Central posterior field, 50° field of view, CFP
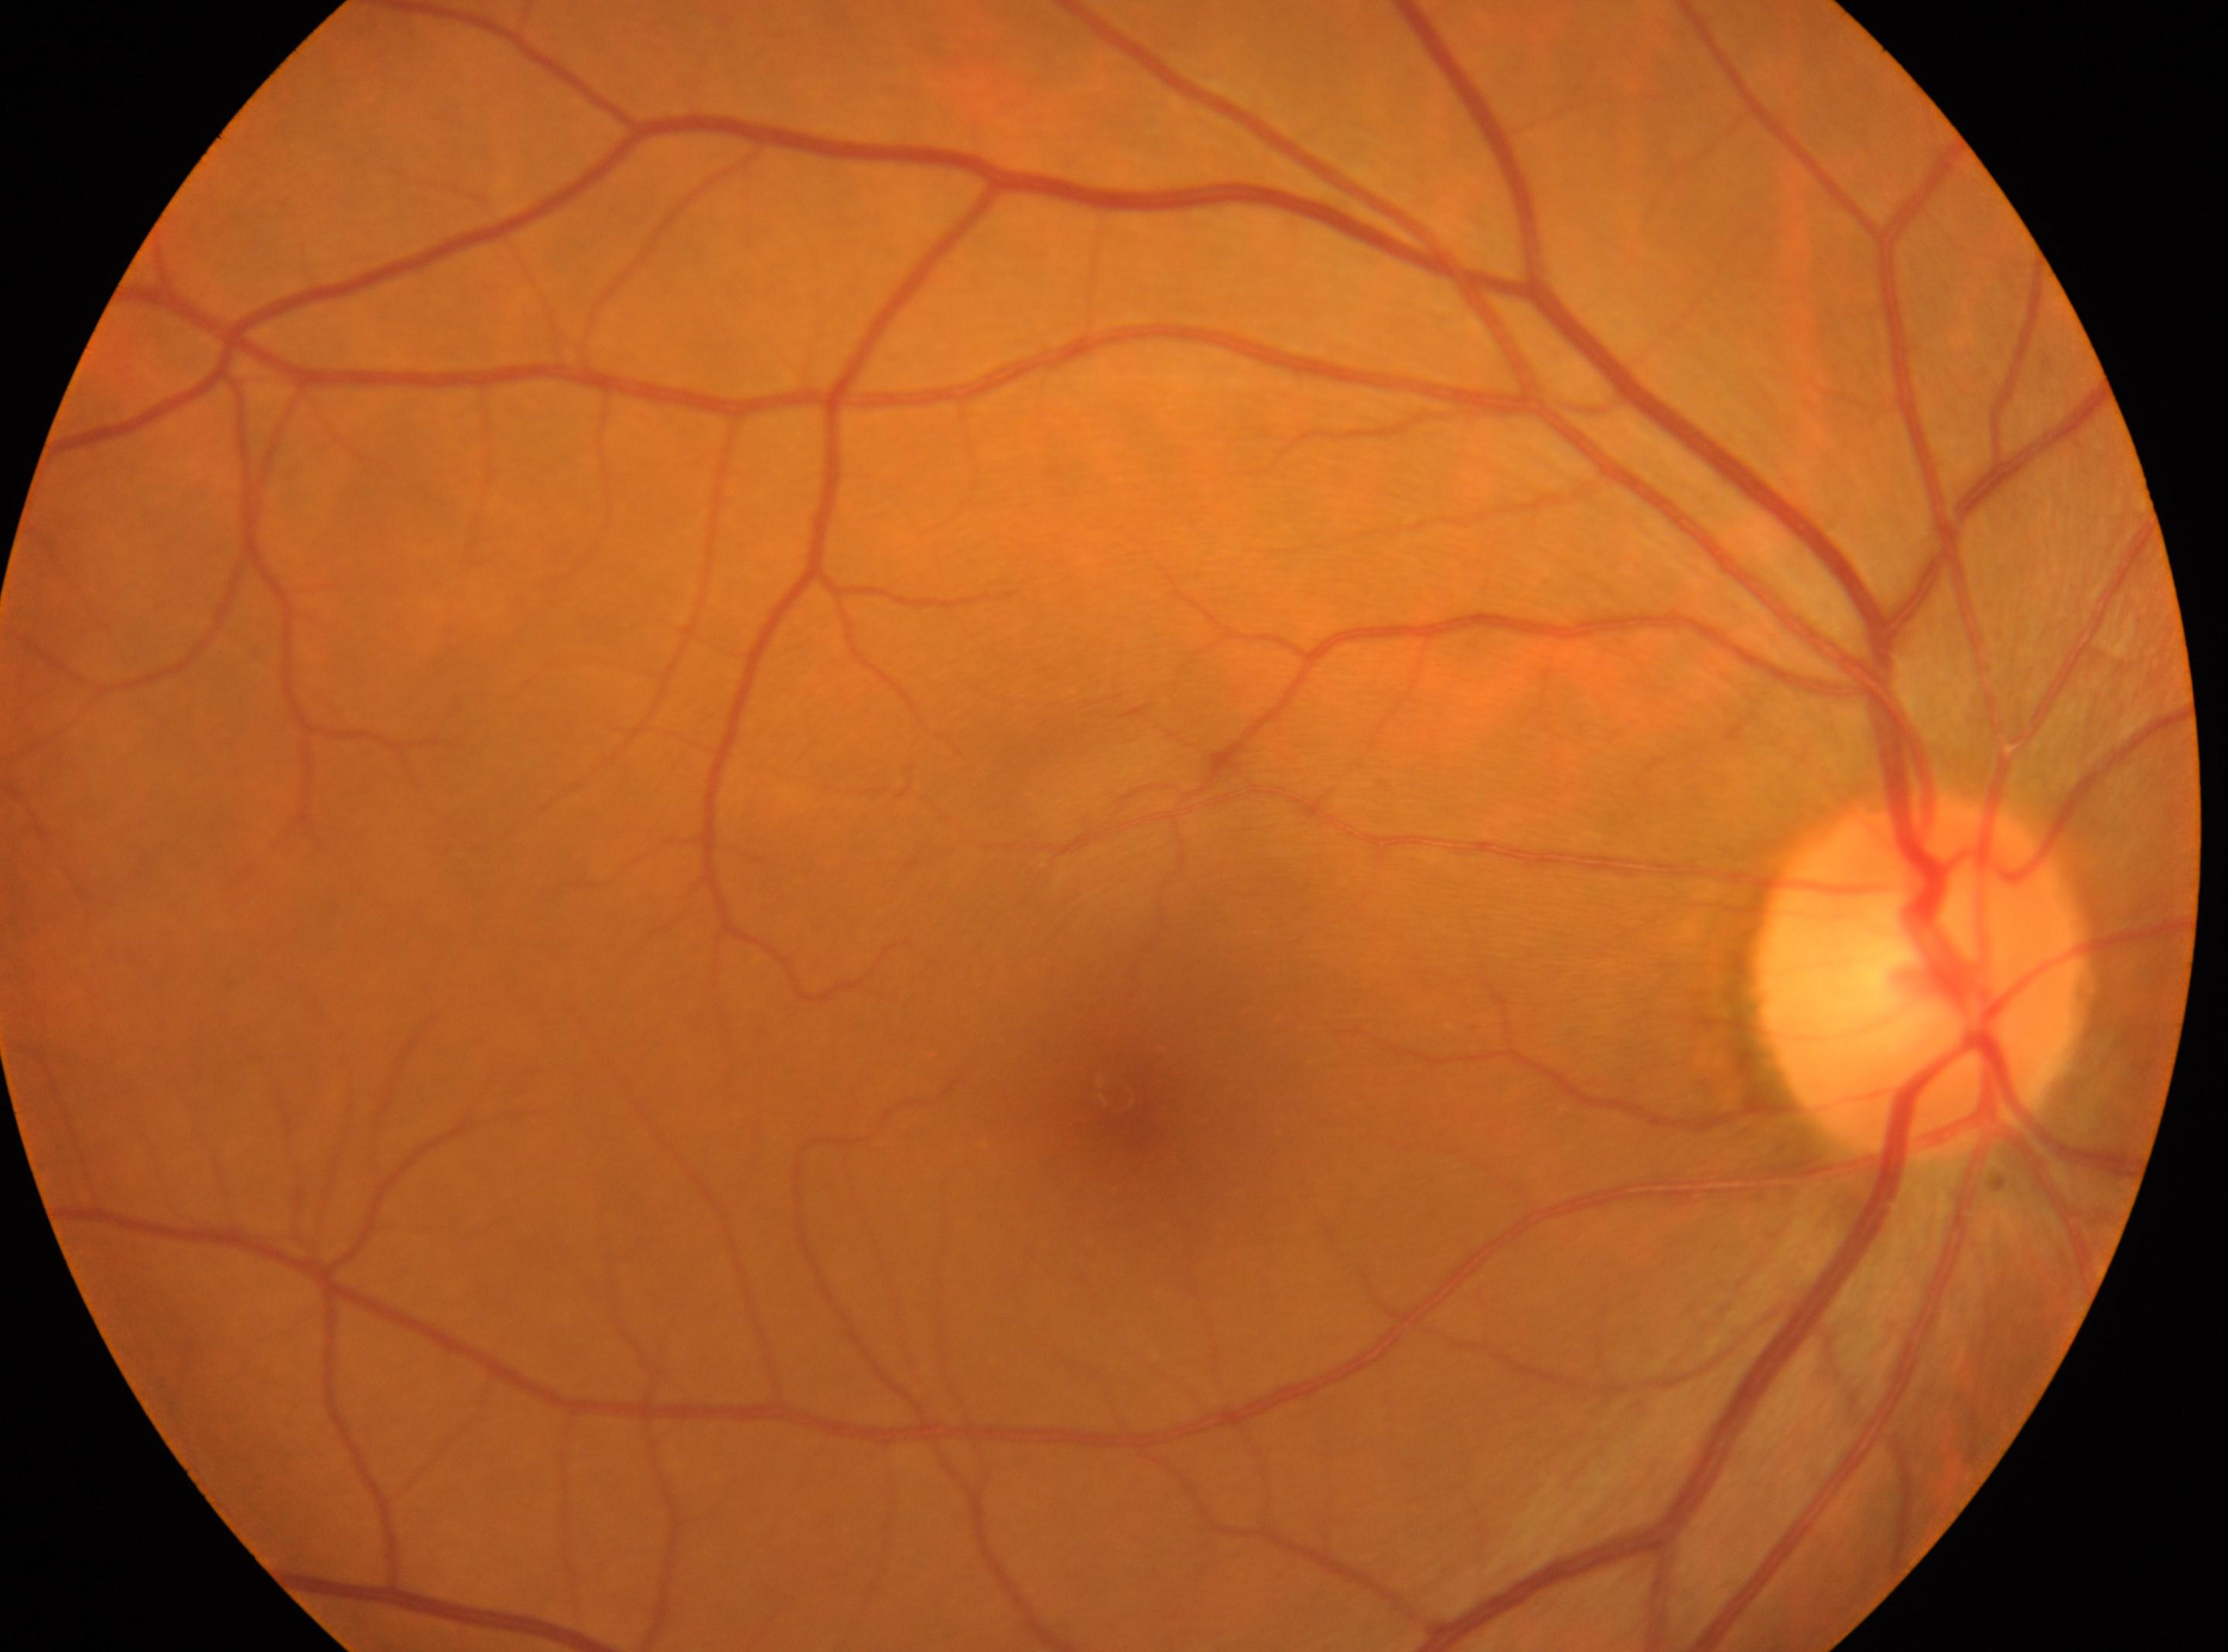 Eye: OD. Optic disc located at (1922,978). Fovea center located at (1116,1095). Diabetic retinopathy (DR): grade 0 (no apparent retinopathy).